2352x1568
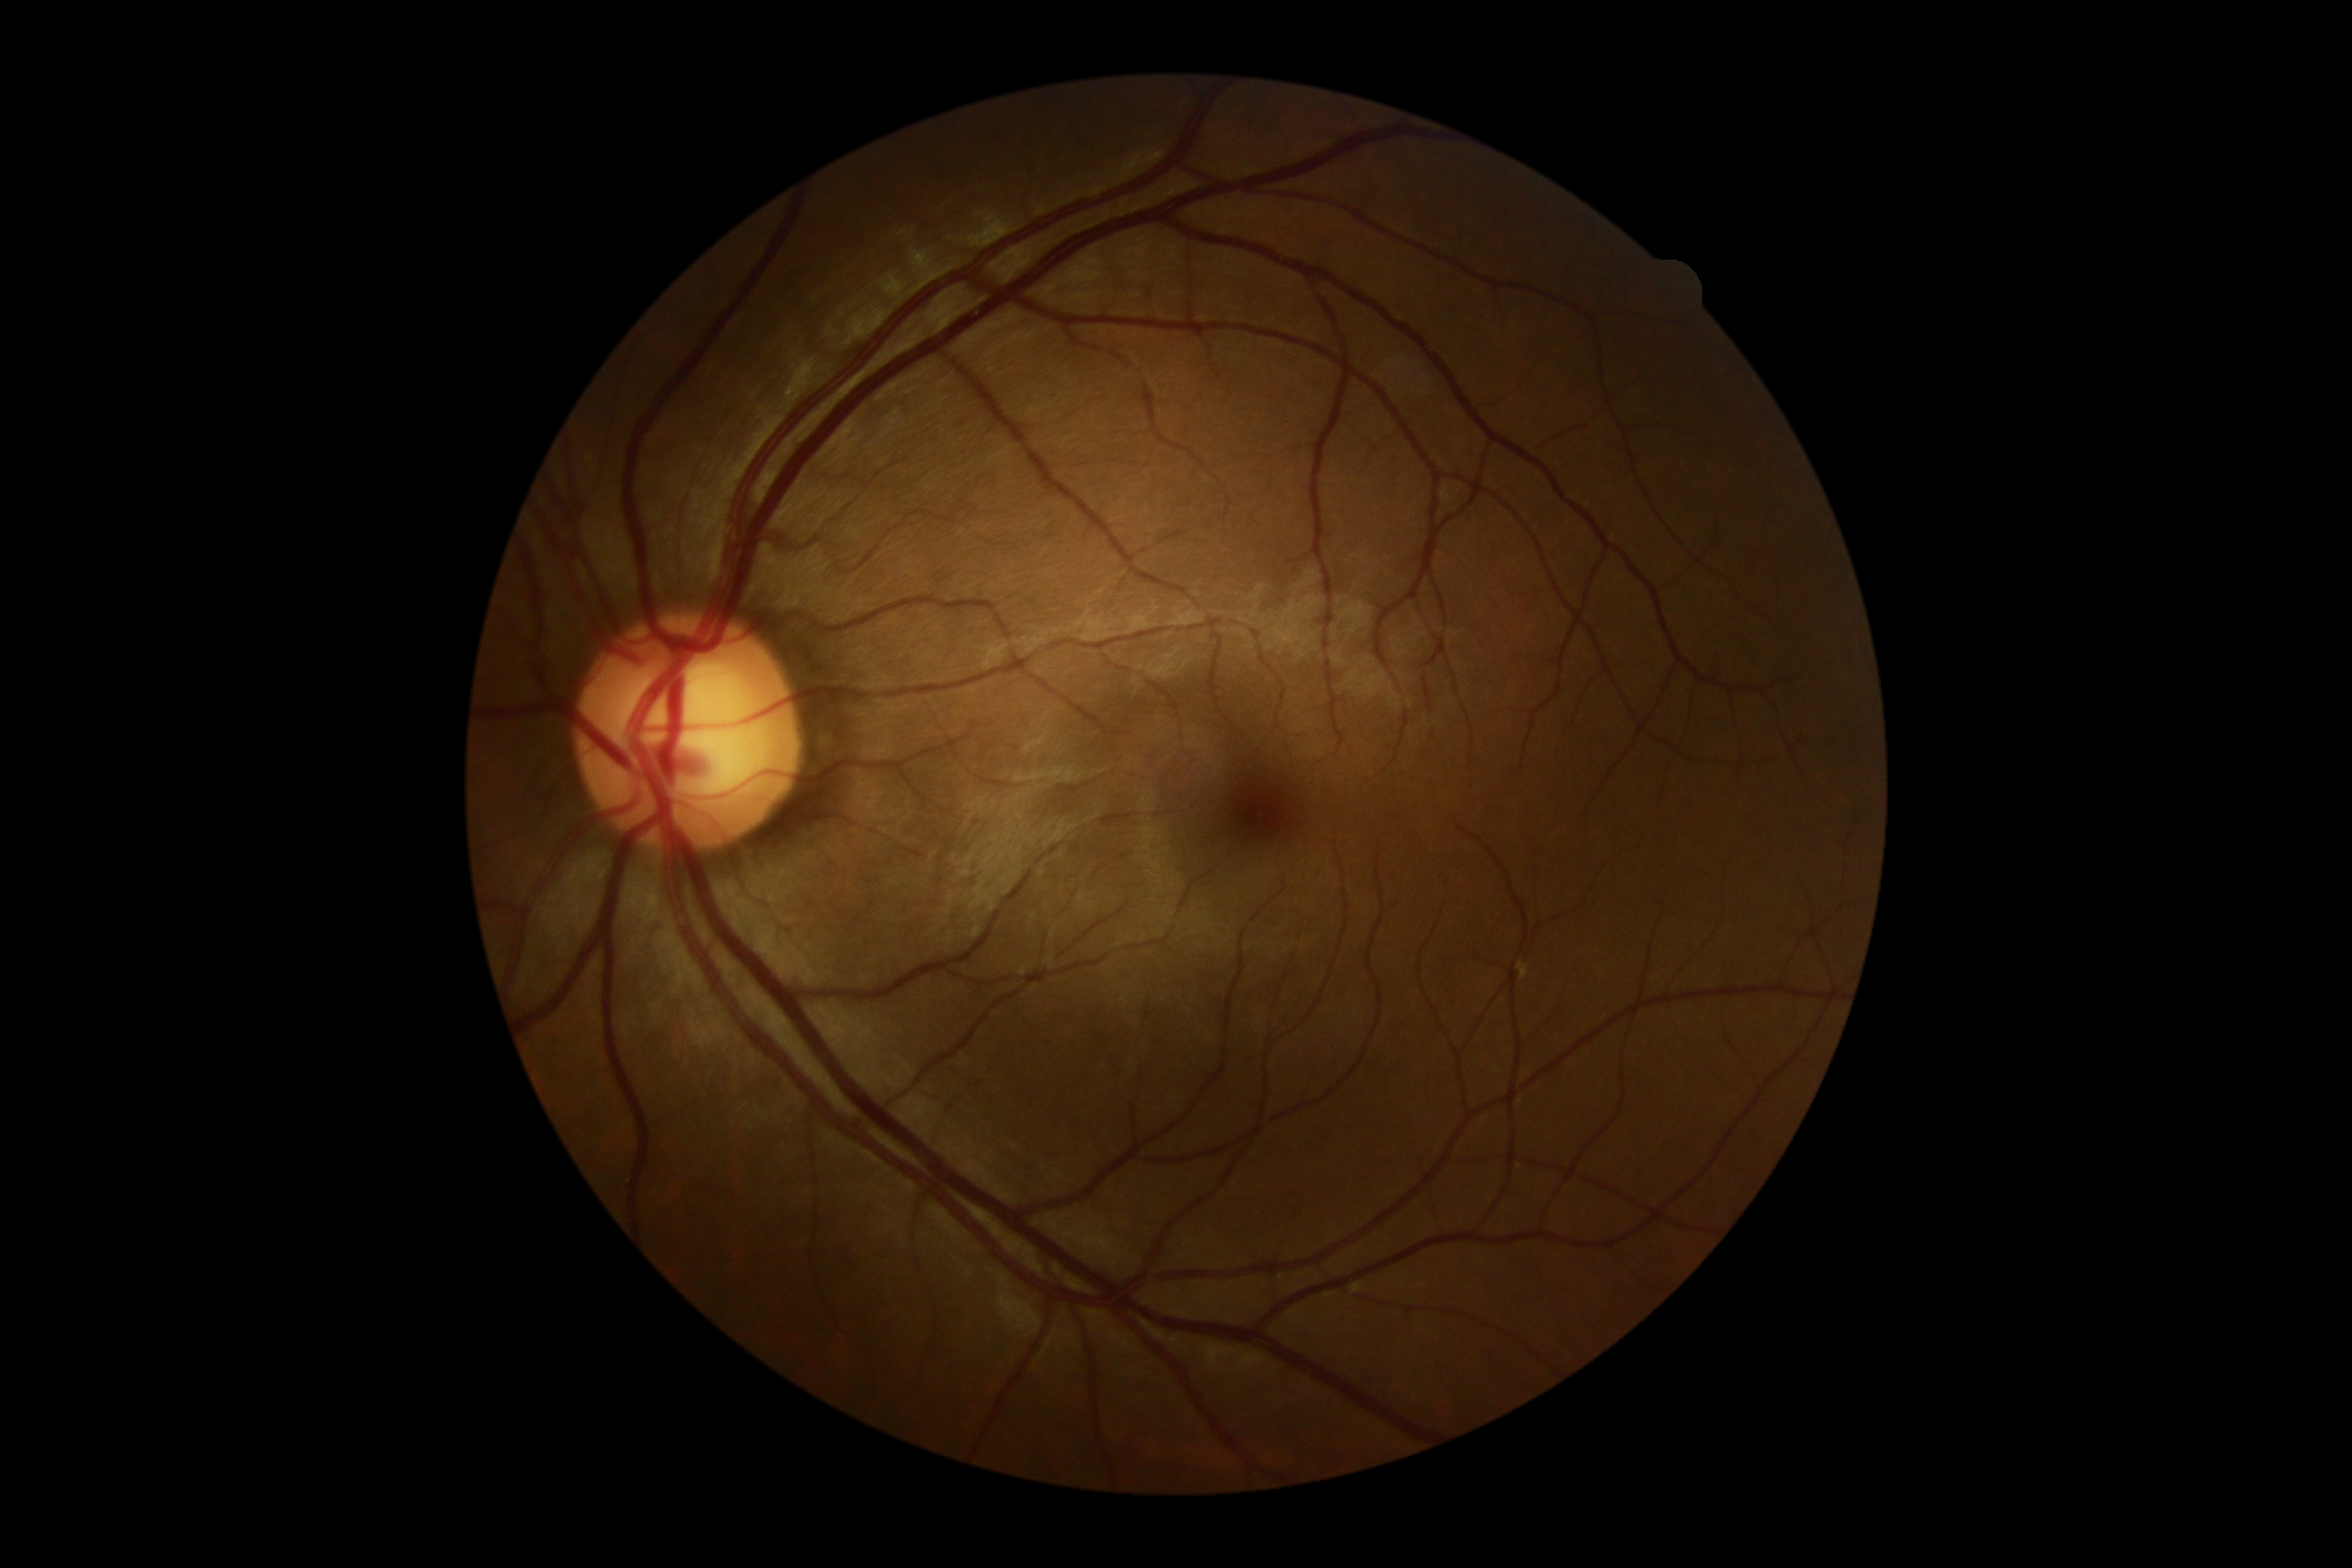 Retinopathy: no apparent retinopathy (grade 0). No apparent diabetic retinopathy.